Color fundus image, 45° field of view, without pupil dilation, 848x848, diabetic retinopathy graded by the modified Davis classification.
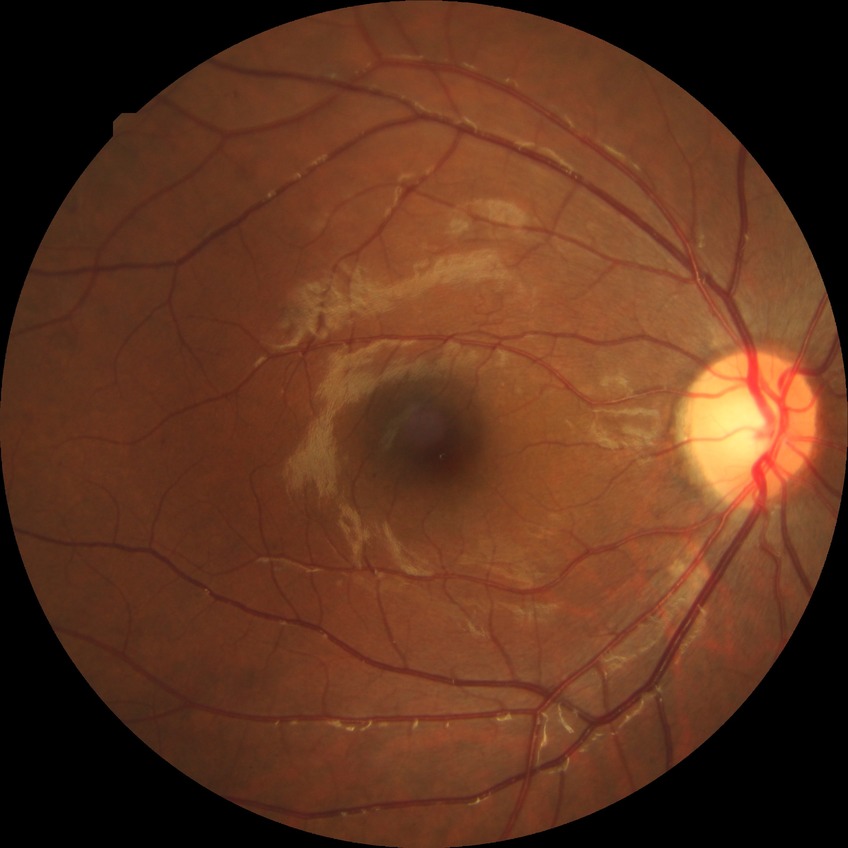 {
  "davis_grade": "SDR (simple diabetic retinopathy)"
}